Retinal fundus photograph; 45-degree field of view.
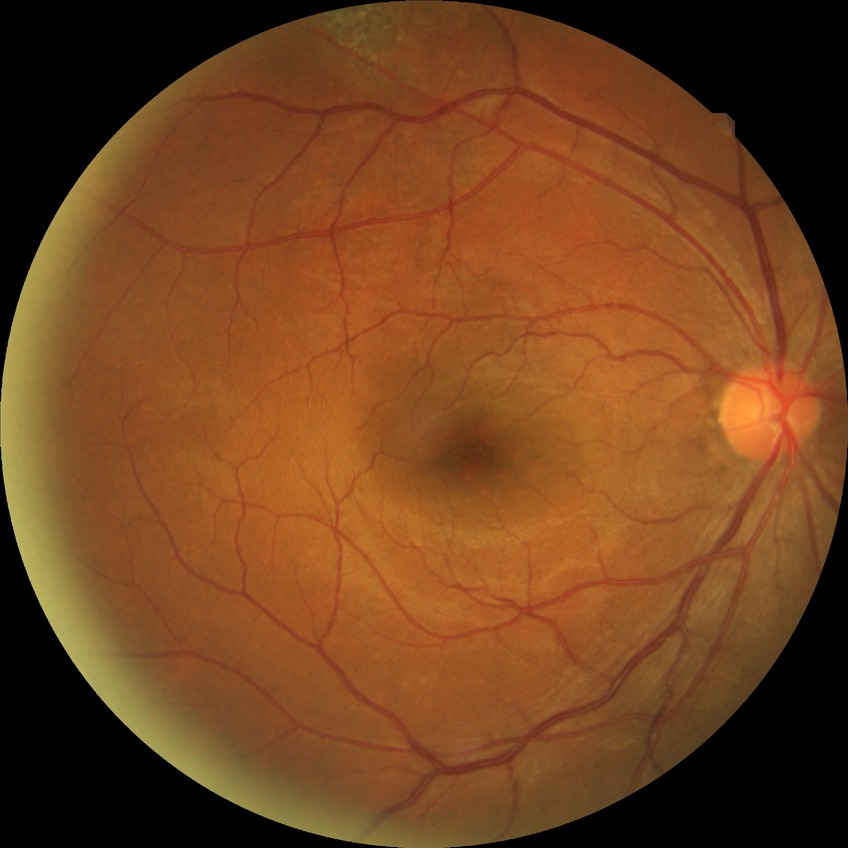
Modified Davis grading is no diabetic retinopathy.